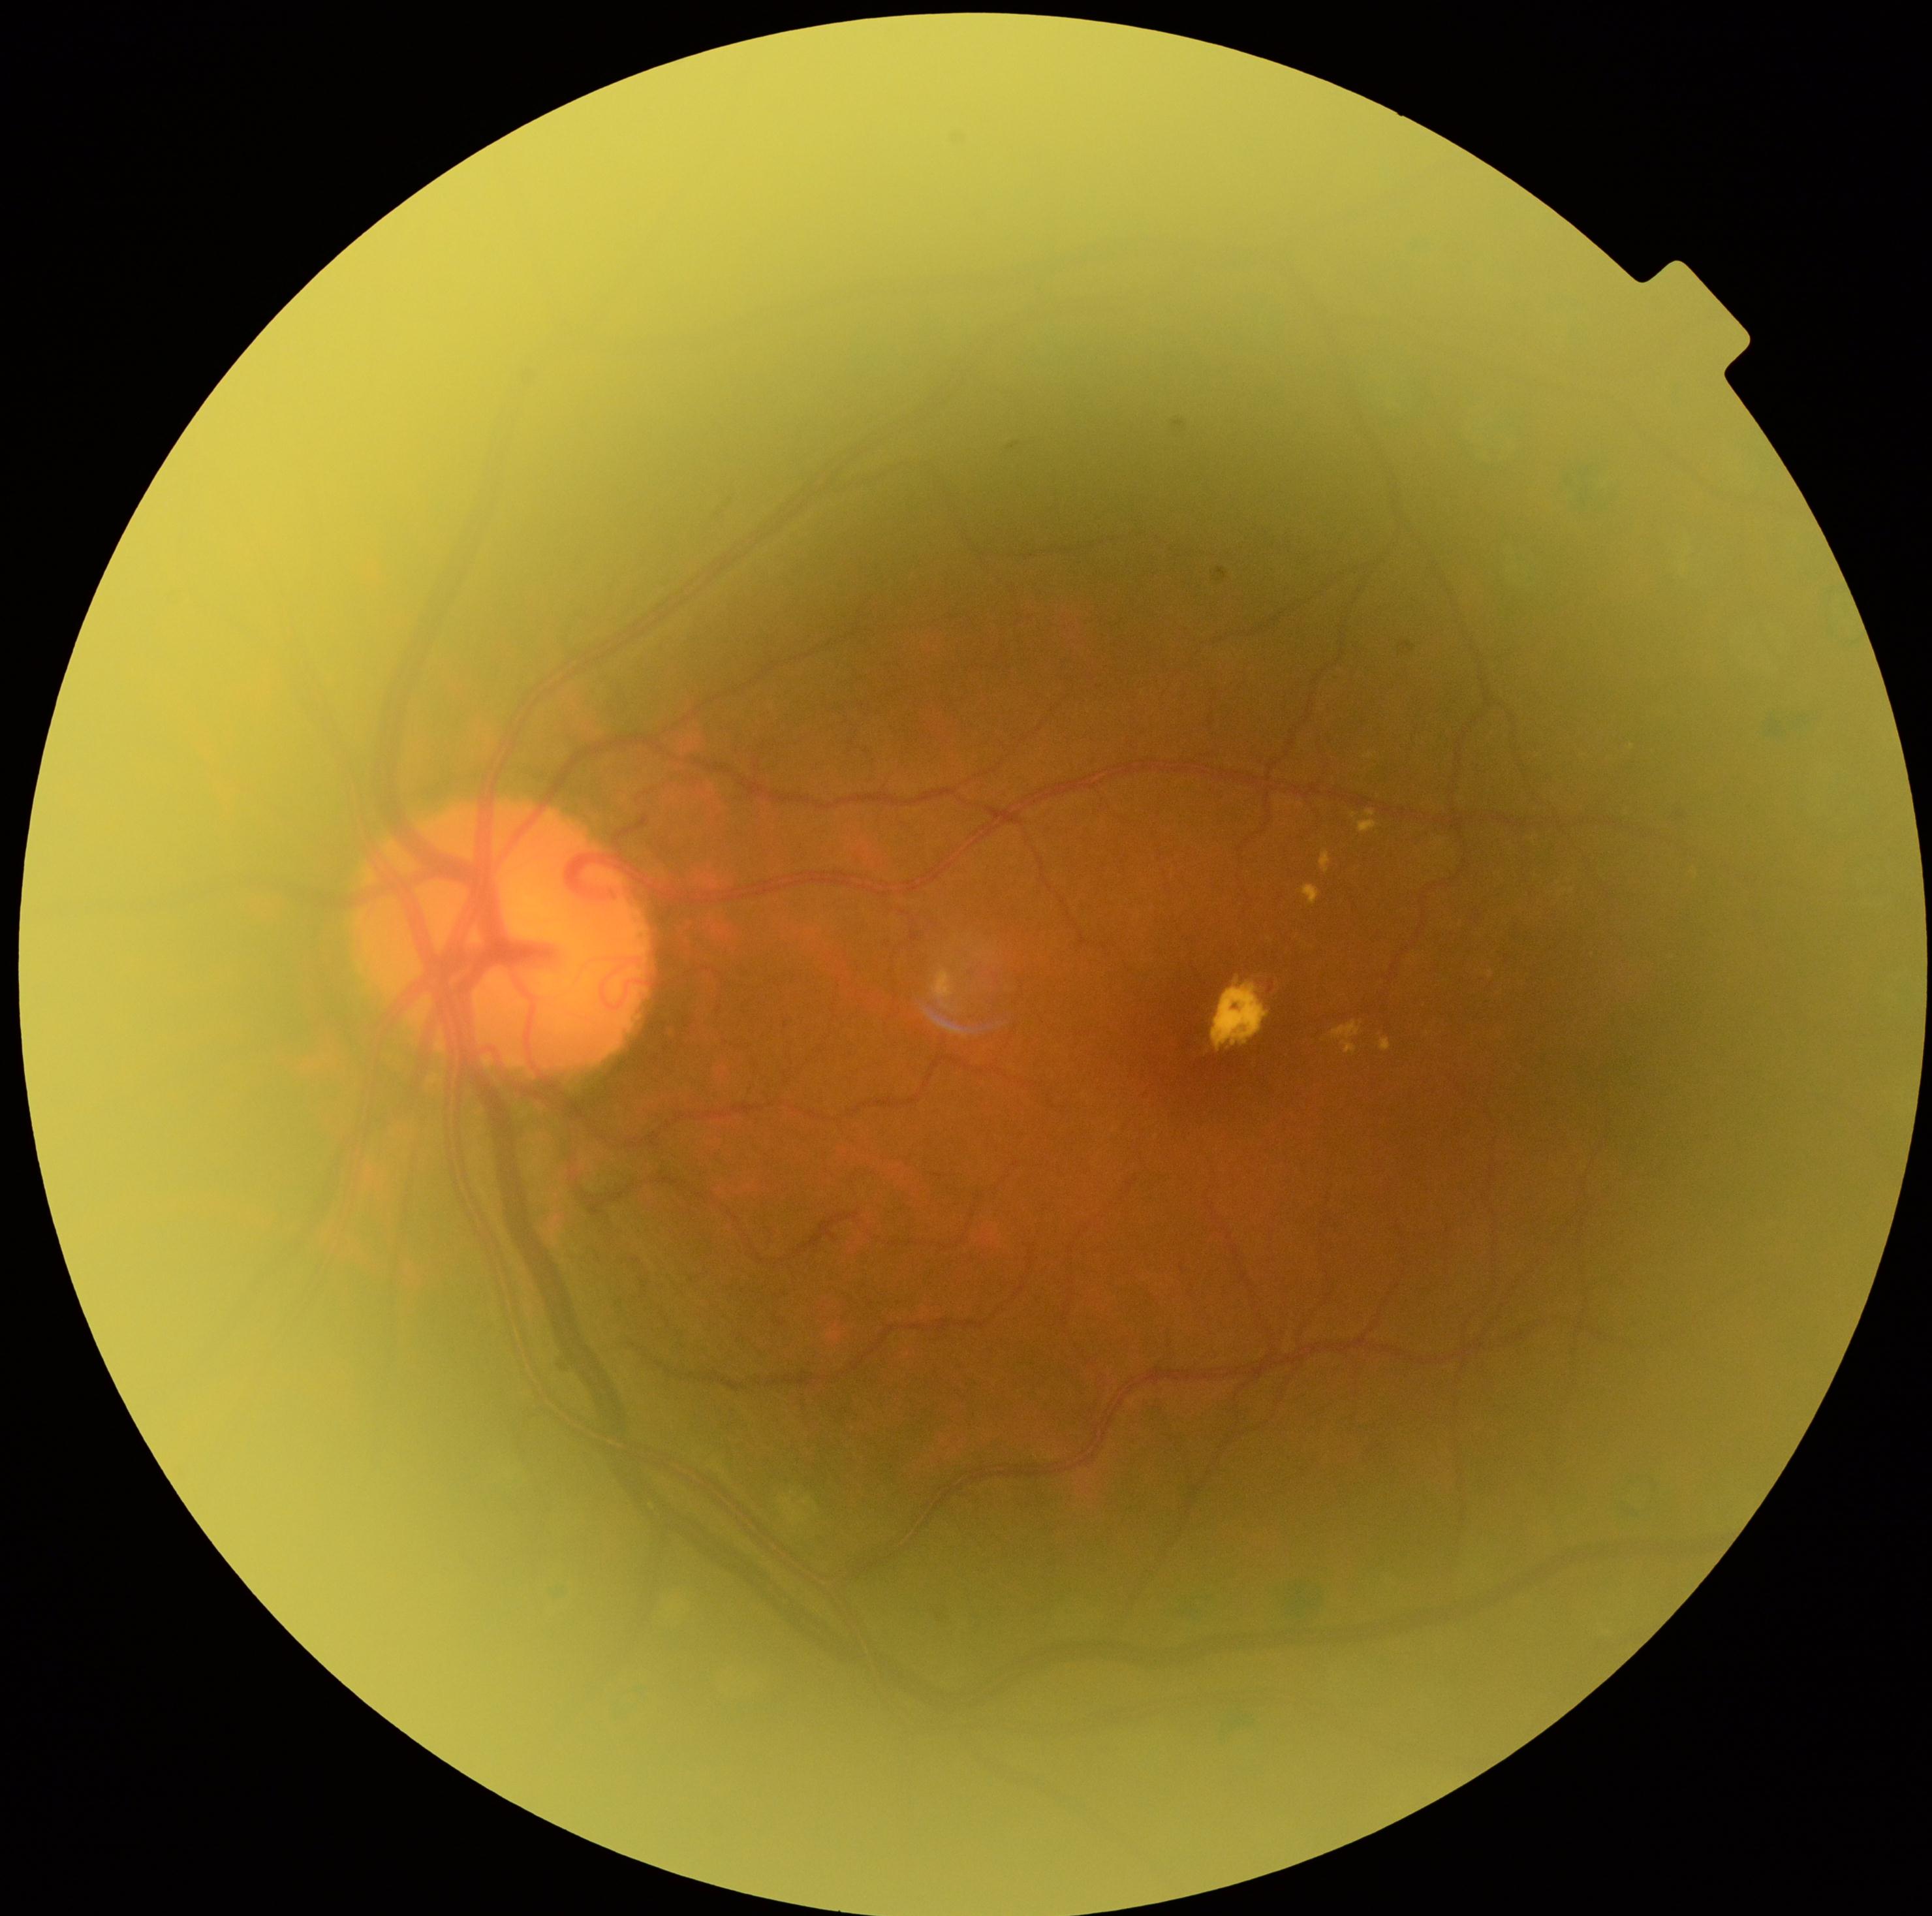 retinopathy: moderate non-proliferative diabetic retinopathy (grade 2)